Wide-field contact fundus photograph of an infant: 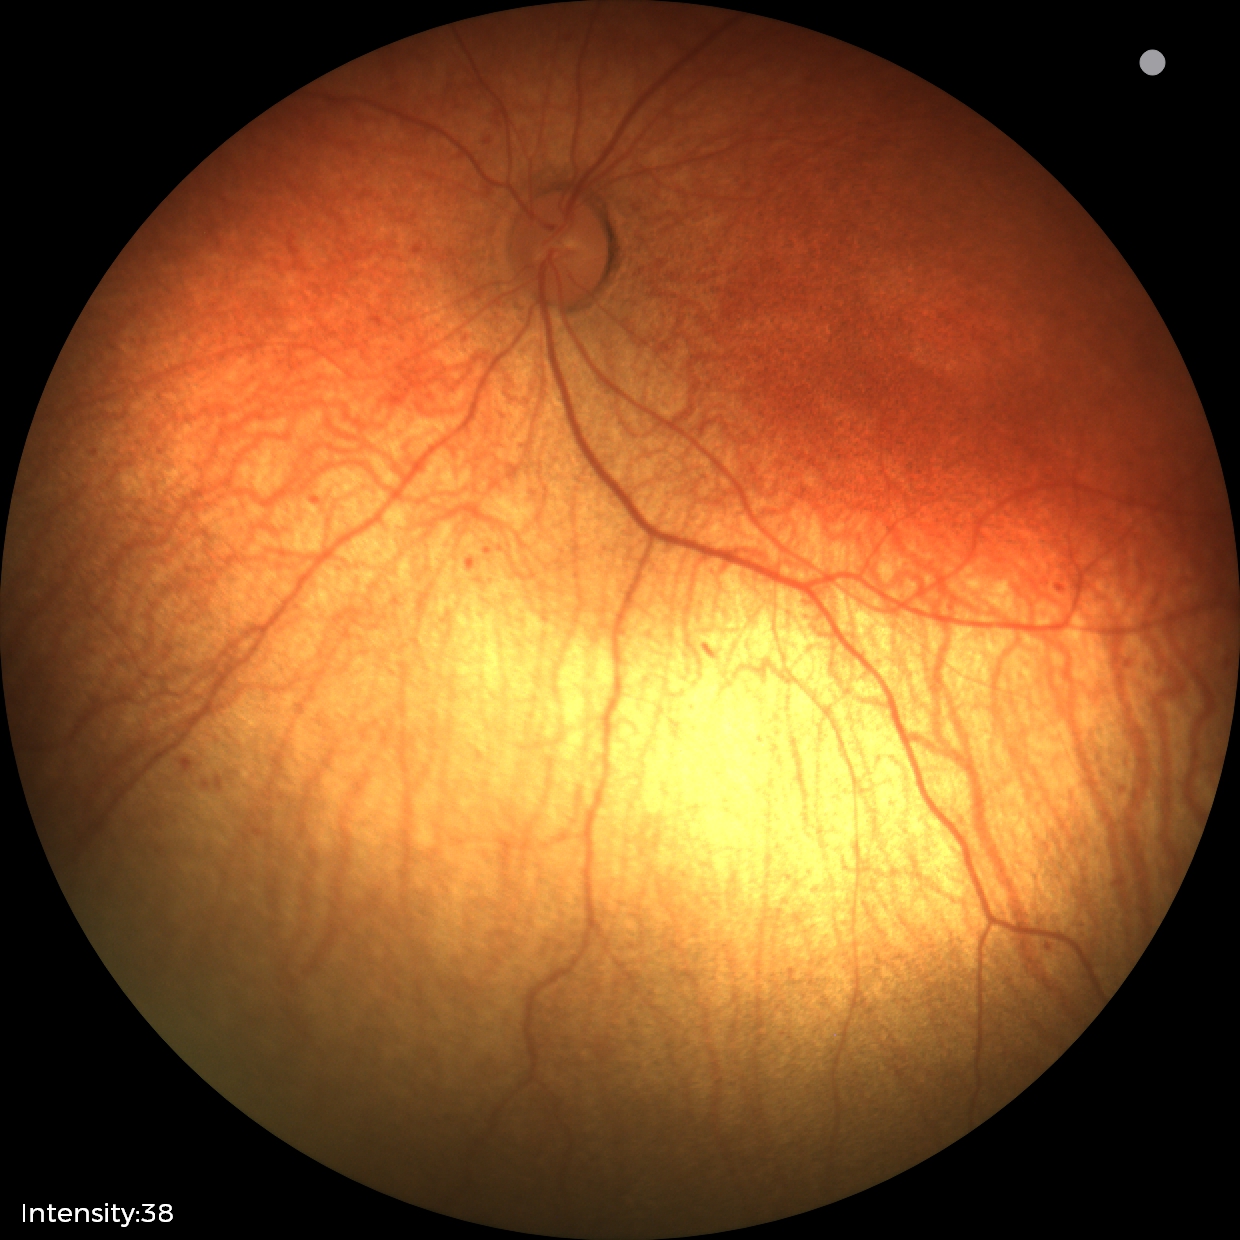

Screening: status post retinopathy of prematurity (ROP) — retinal appearance after treated retinopathy of prematurity; no plus disease — posterior pole vessels without abnormal dilation or tortuosity.